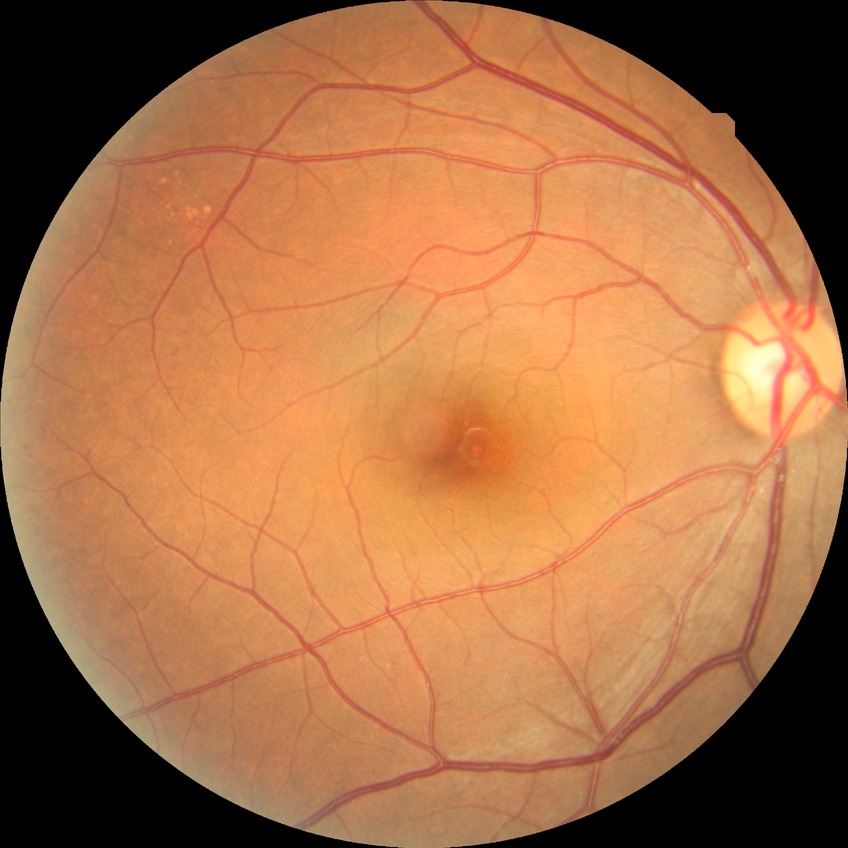 DR severity is NDR.